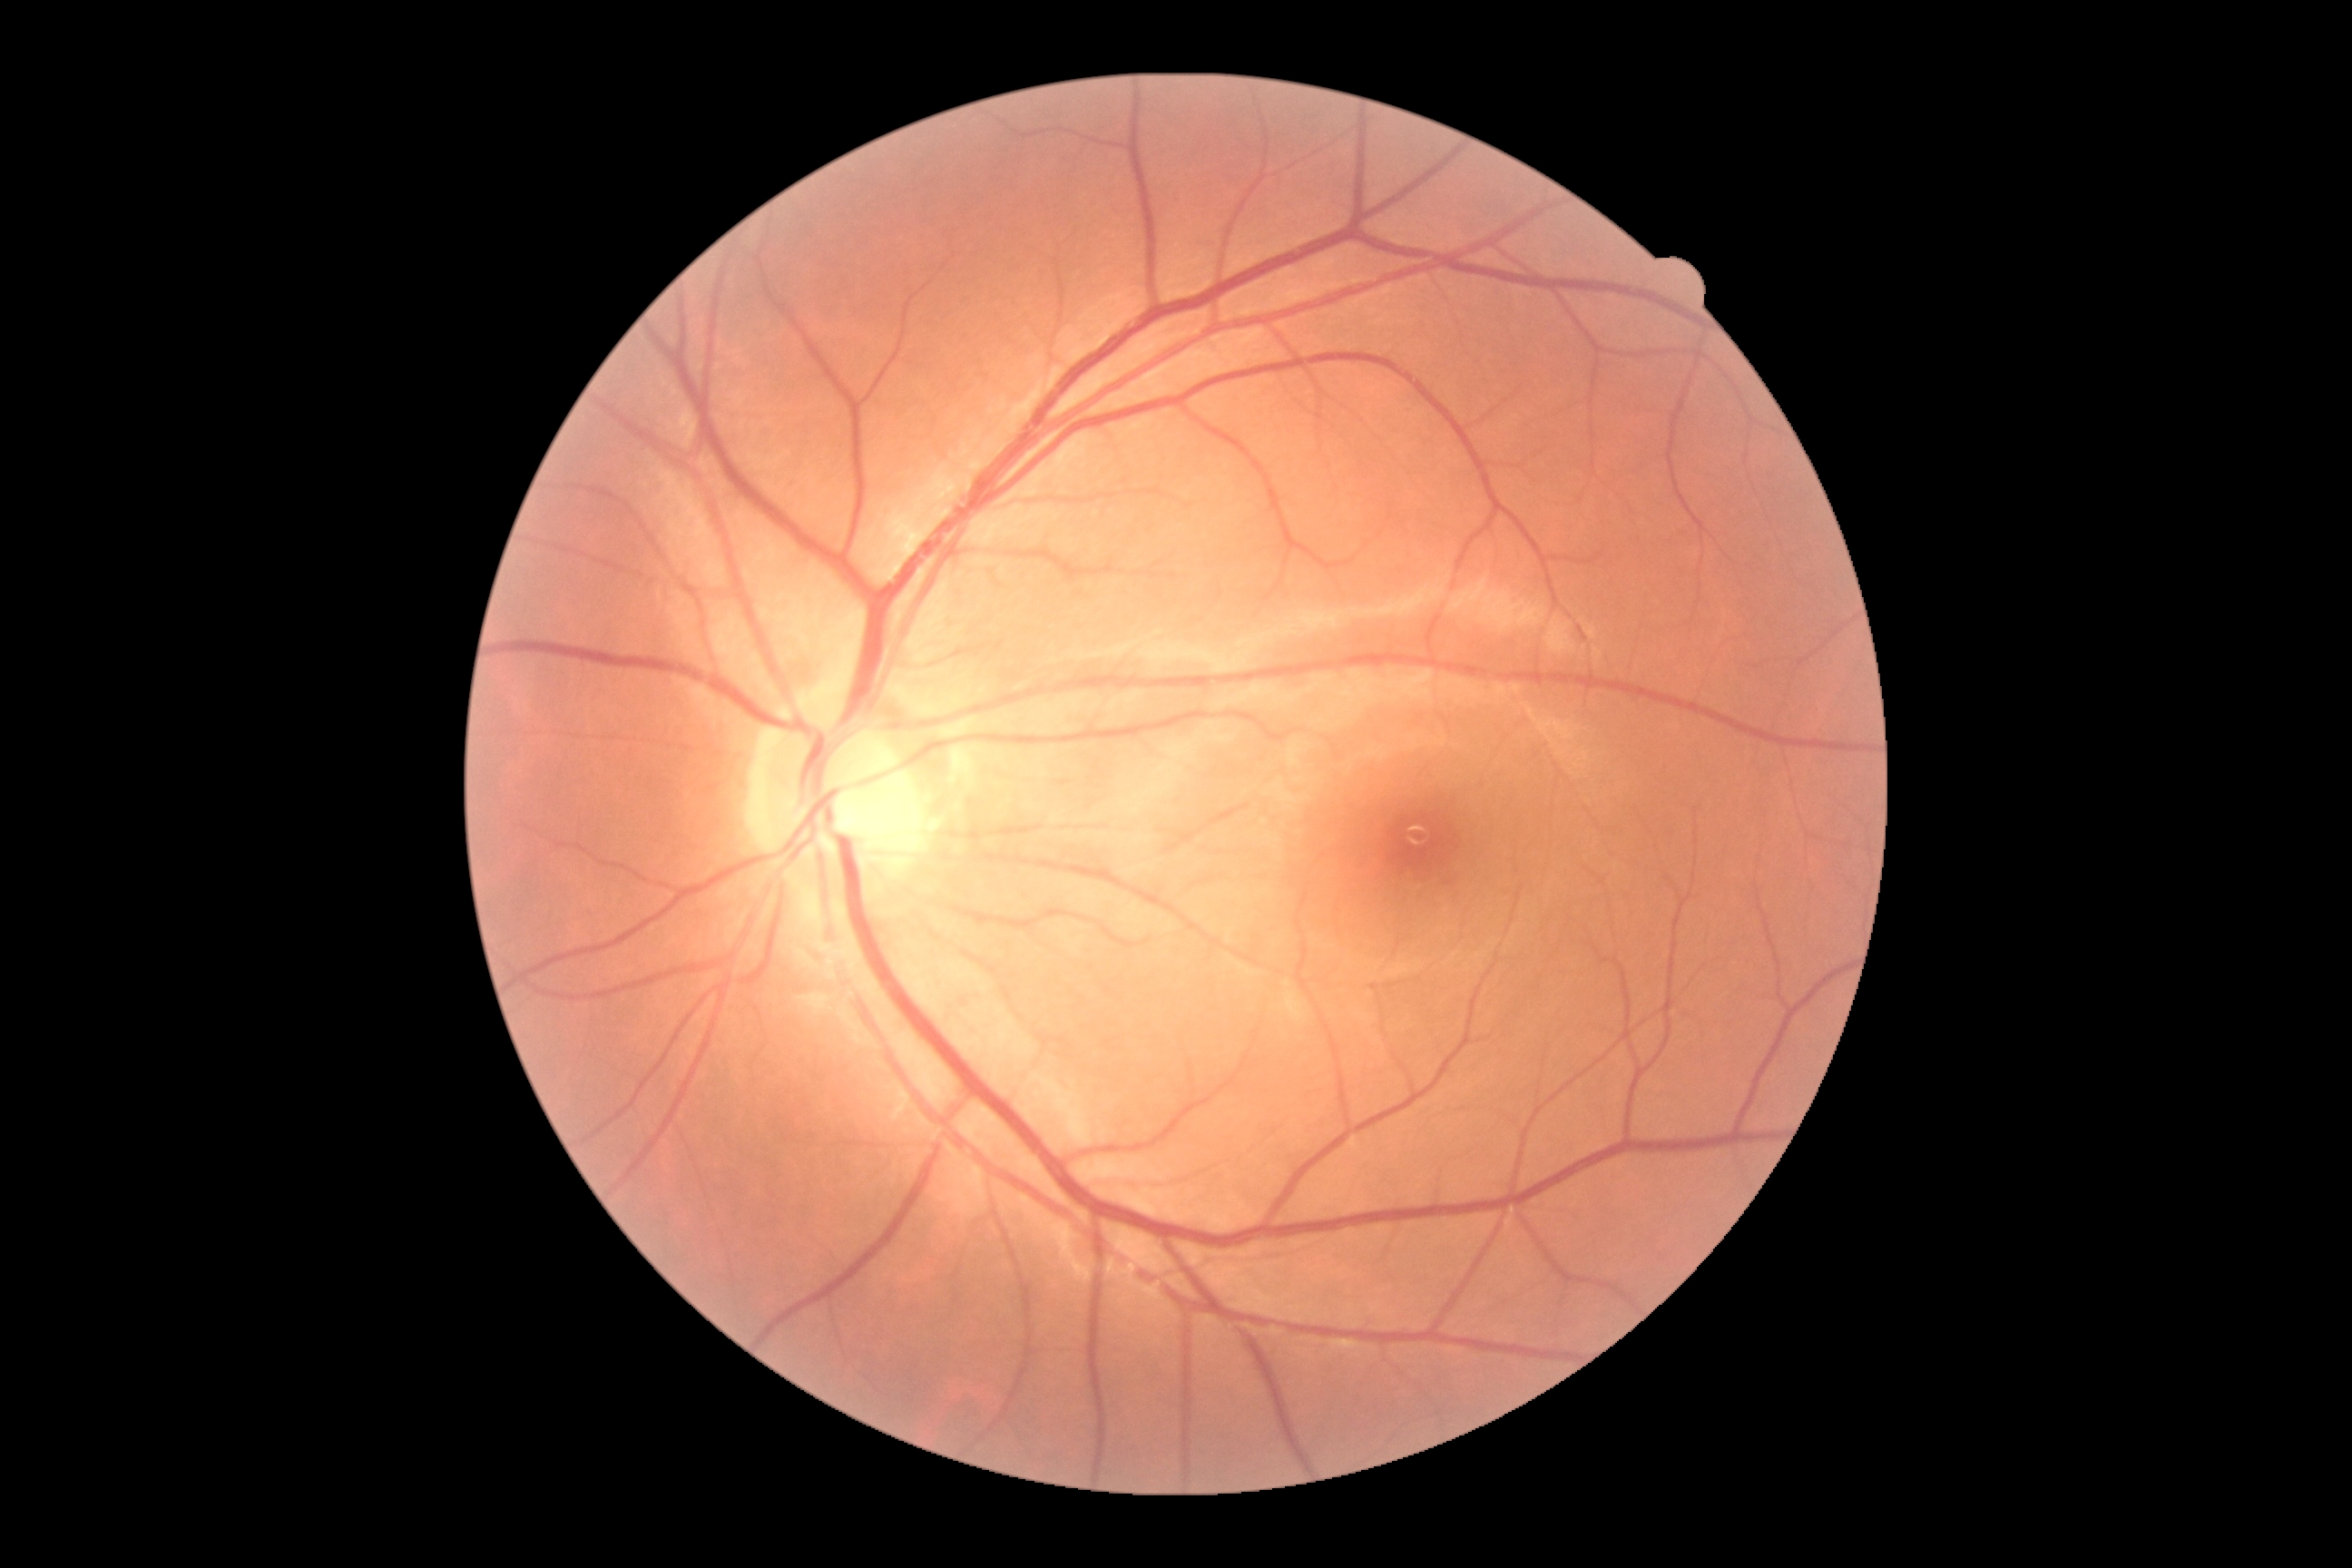
{"dr_grade": "grade 0 (no apparent retinopathy)"}